Camera: Phoenix ICON (100° FOV). Pediatric retinal photograph (wide-field): 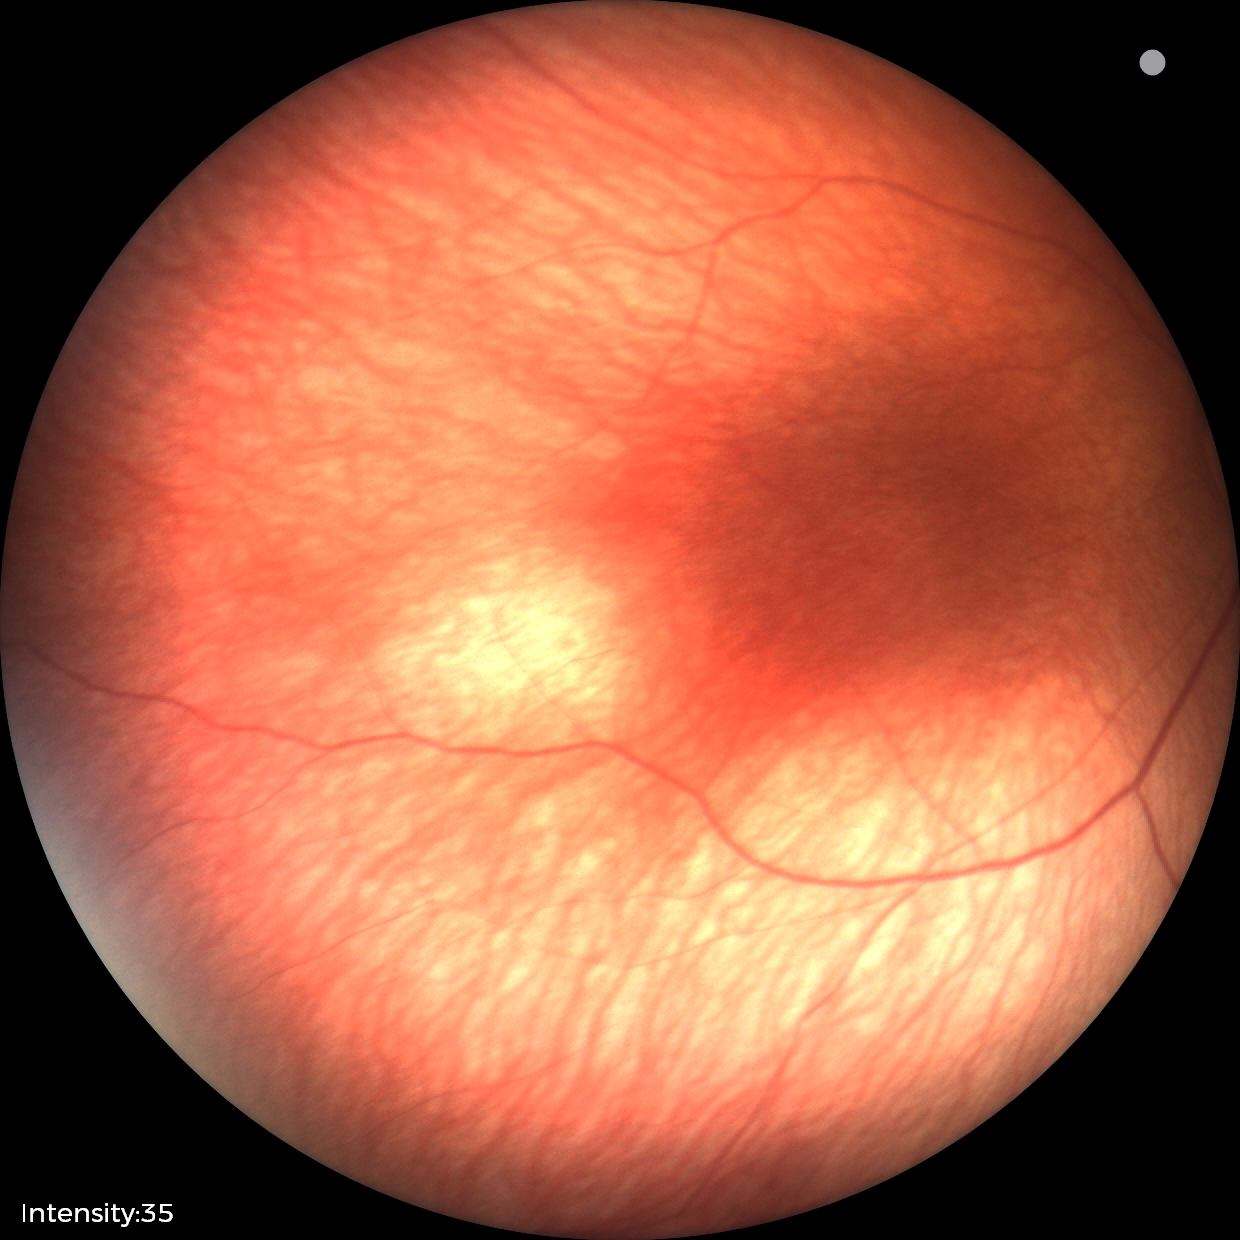

Q: What is the diagnosis from this examination?
A: normal fundus examination